Non-mydriatic; optic nerve head crop — 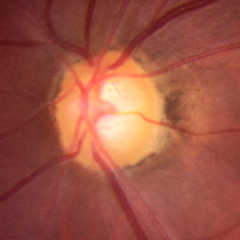

No evidence of glaucoma.